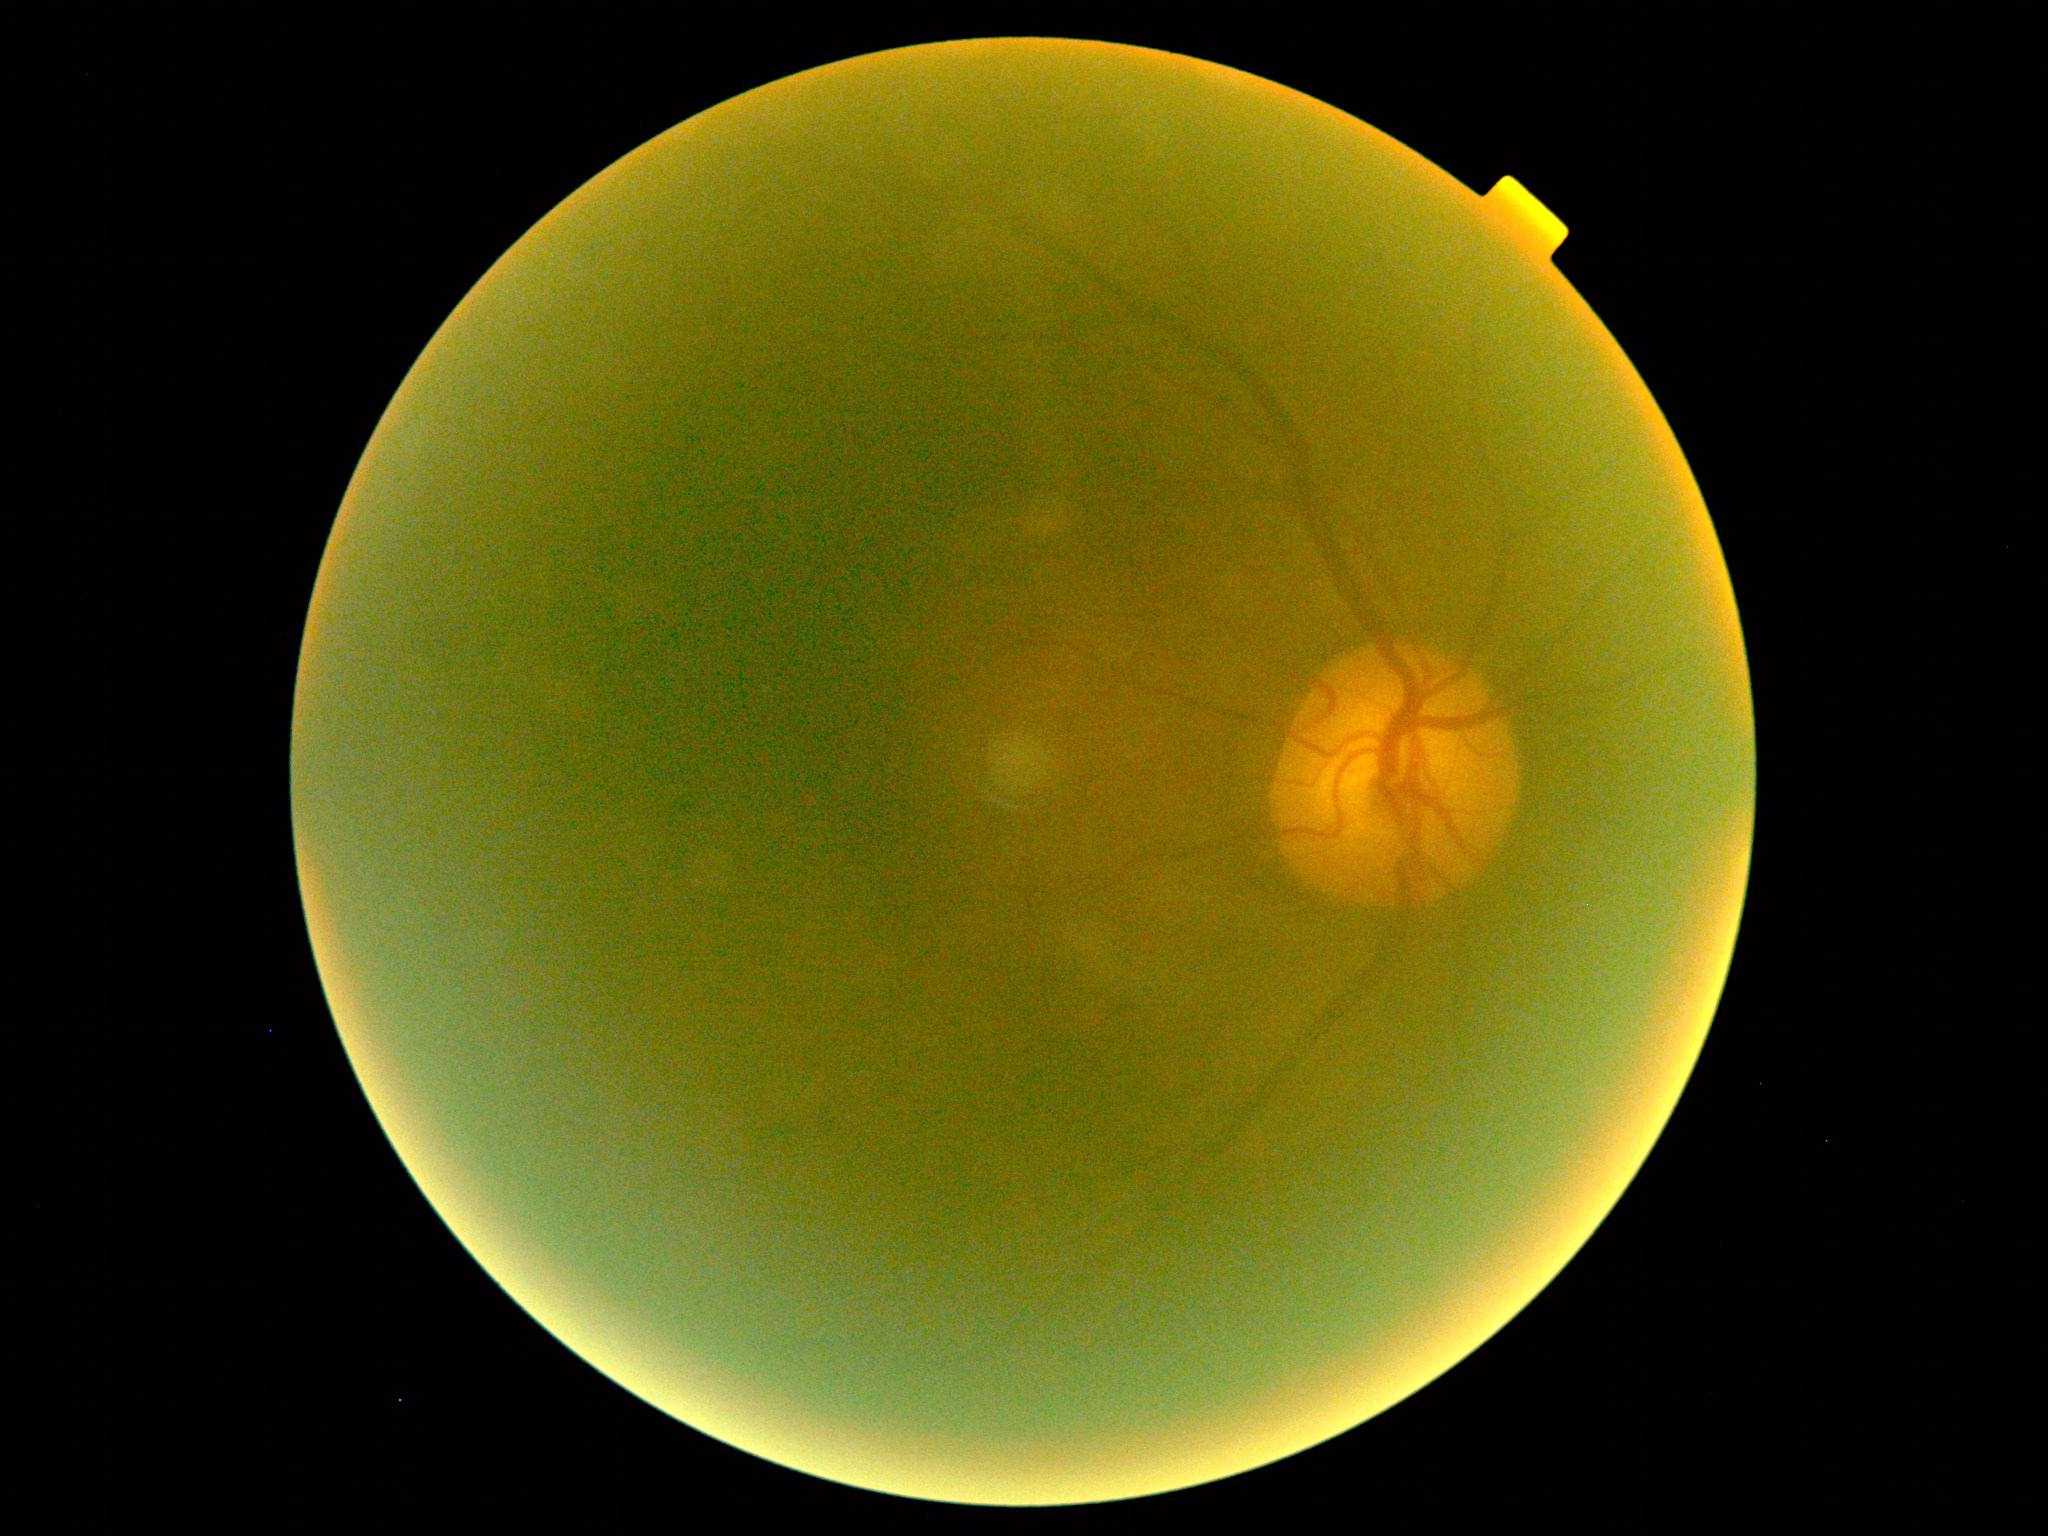

diabetic retinopathy severity = ungradable due to poor image quality, image quality = too poor for DR grading.